Acquired with a Remidio smartphone fundus camera; 1659x2212.
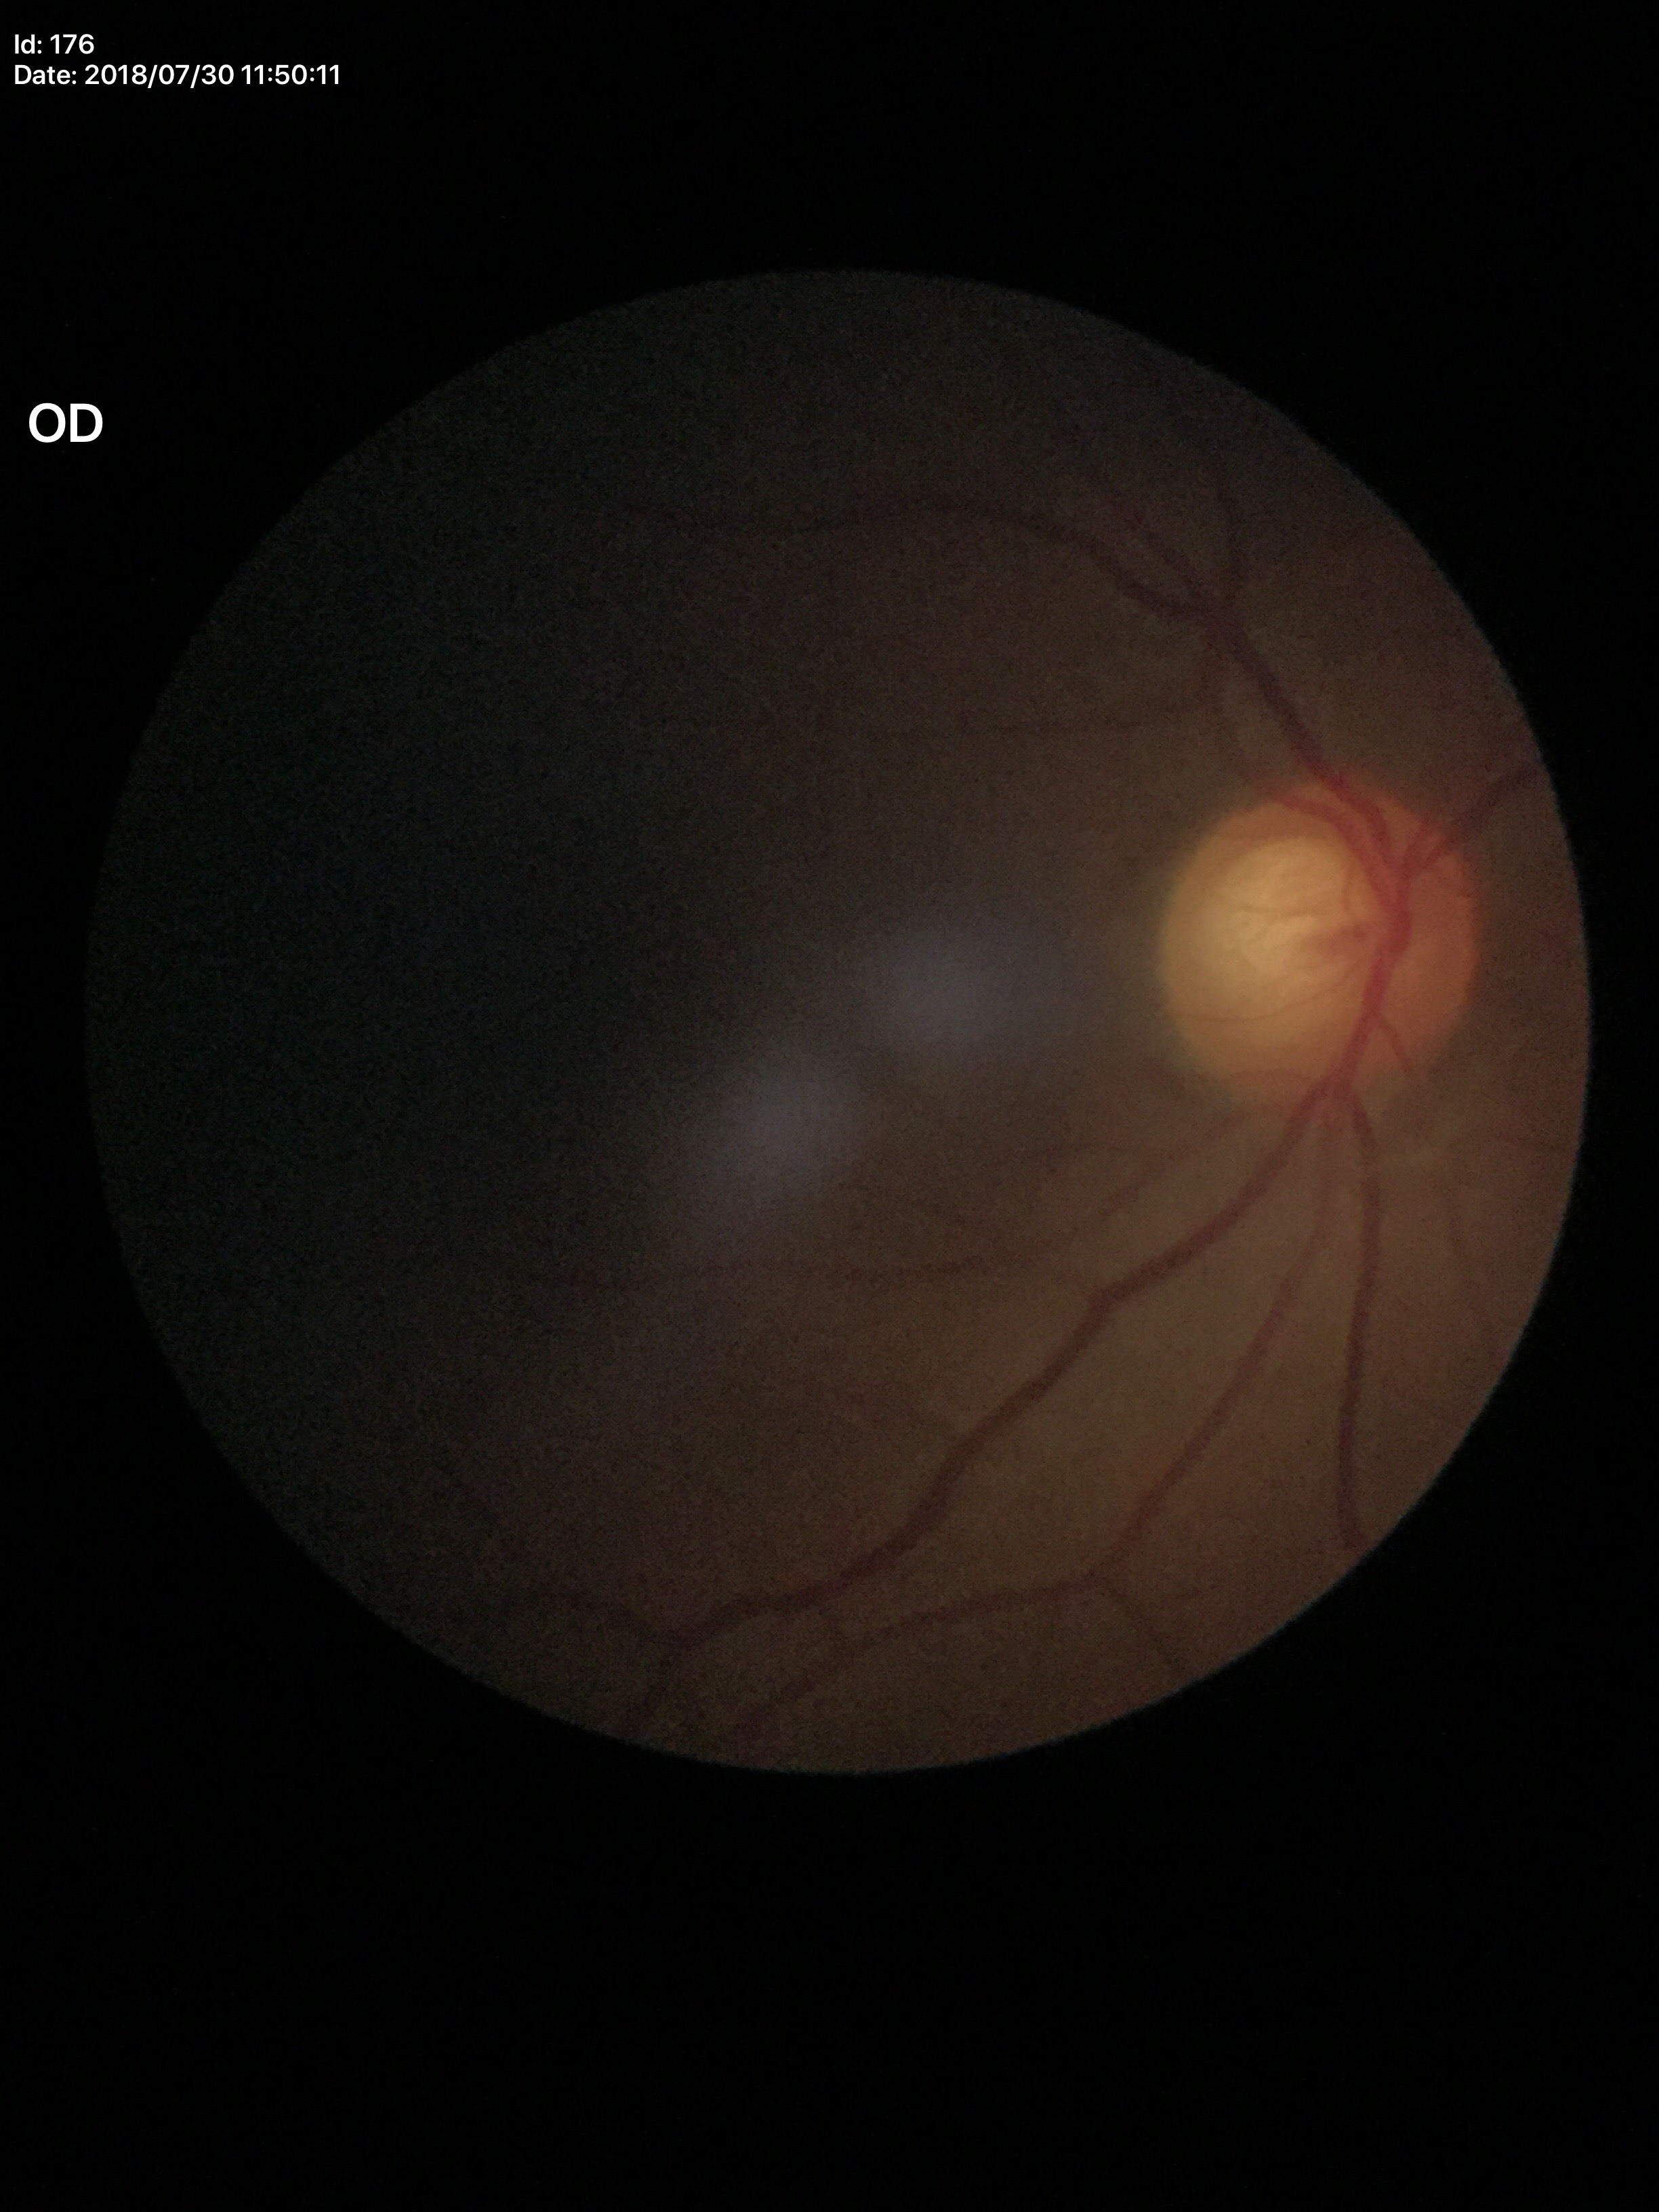
Vertical cup-to-disc ratio of 0.65. Glaucoma suspect (4 of 5 graders flagged glaucoma suspect). Area CDR: 0.43. Horizontal CDR is 0.68.